50° FOV. Mydriatic (tropicamide and phenylephrine). Fundus photo. Posterior pole view.
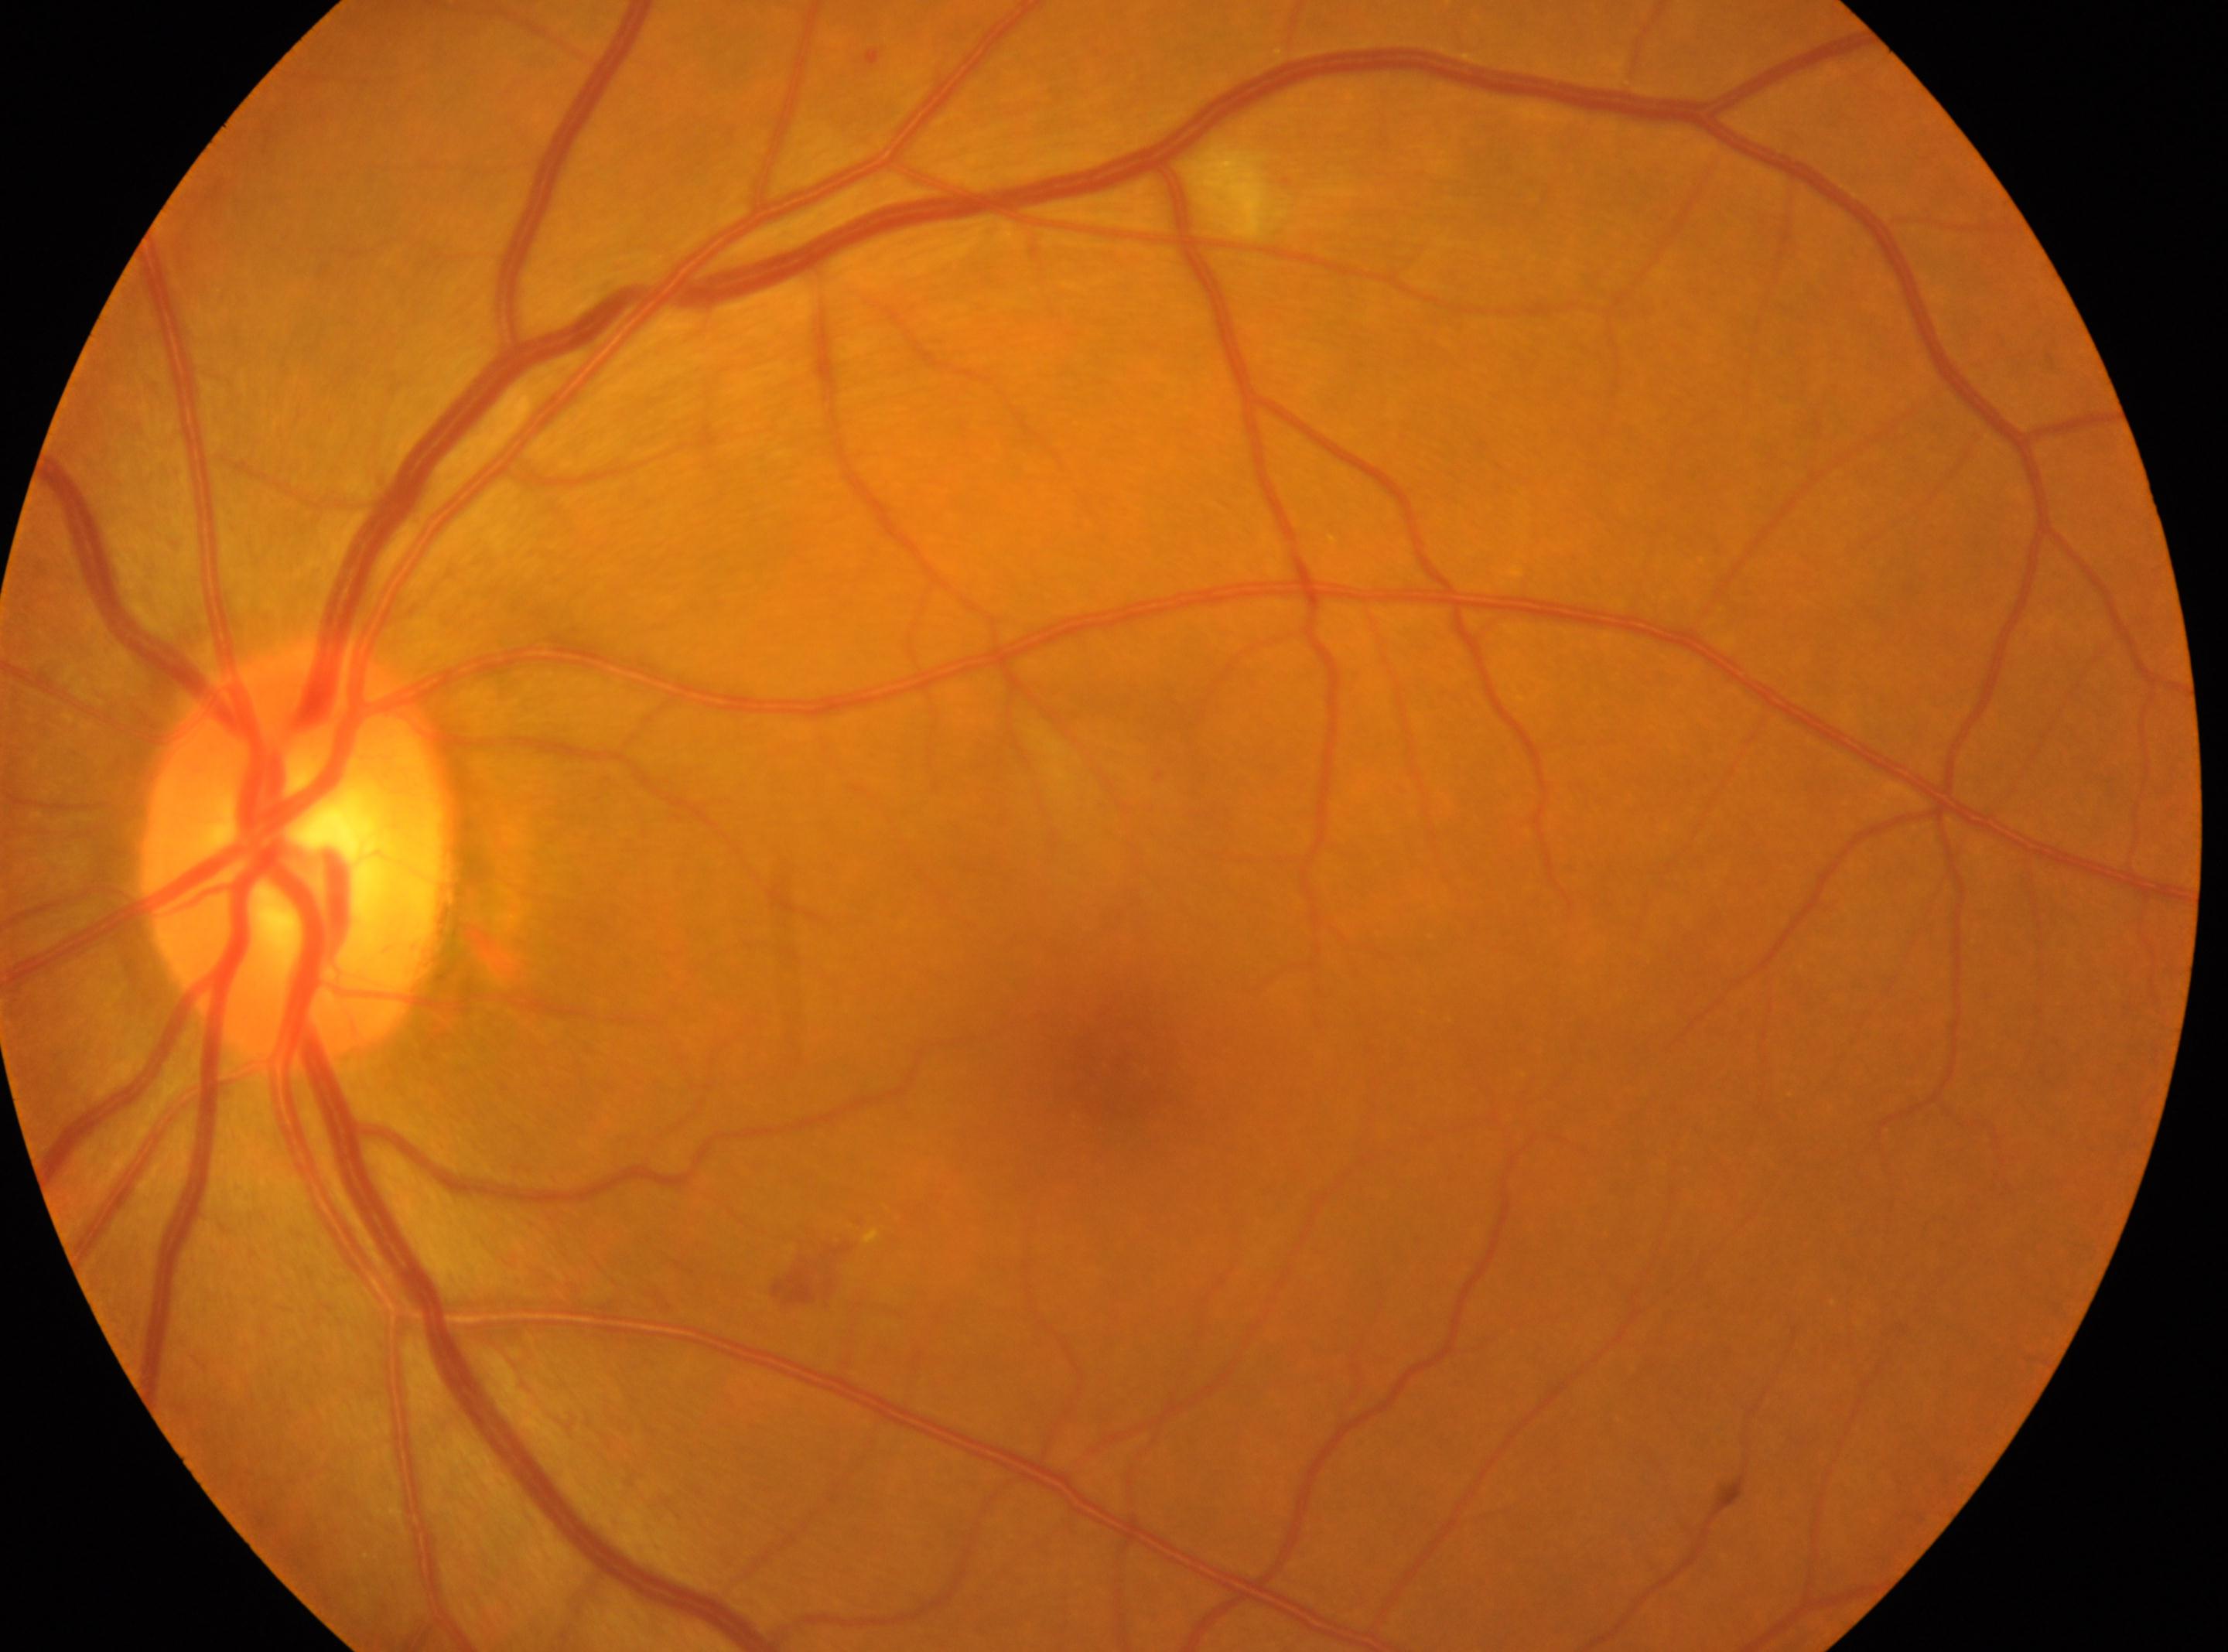

The image shows the oculus sinister. Optic disc center: (x=292, y=853). Fovea: (x=1112, y=1063). DR class: non-proliferative diabetic retinopathy. DR: moderate non-proliferative diabetic retinopathy (grade 2).